45-degree field of view
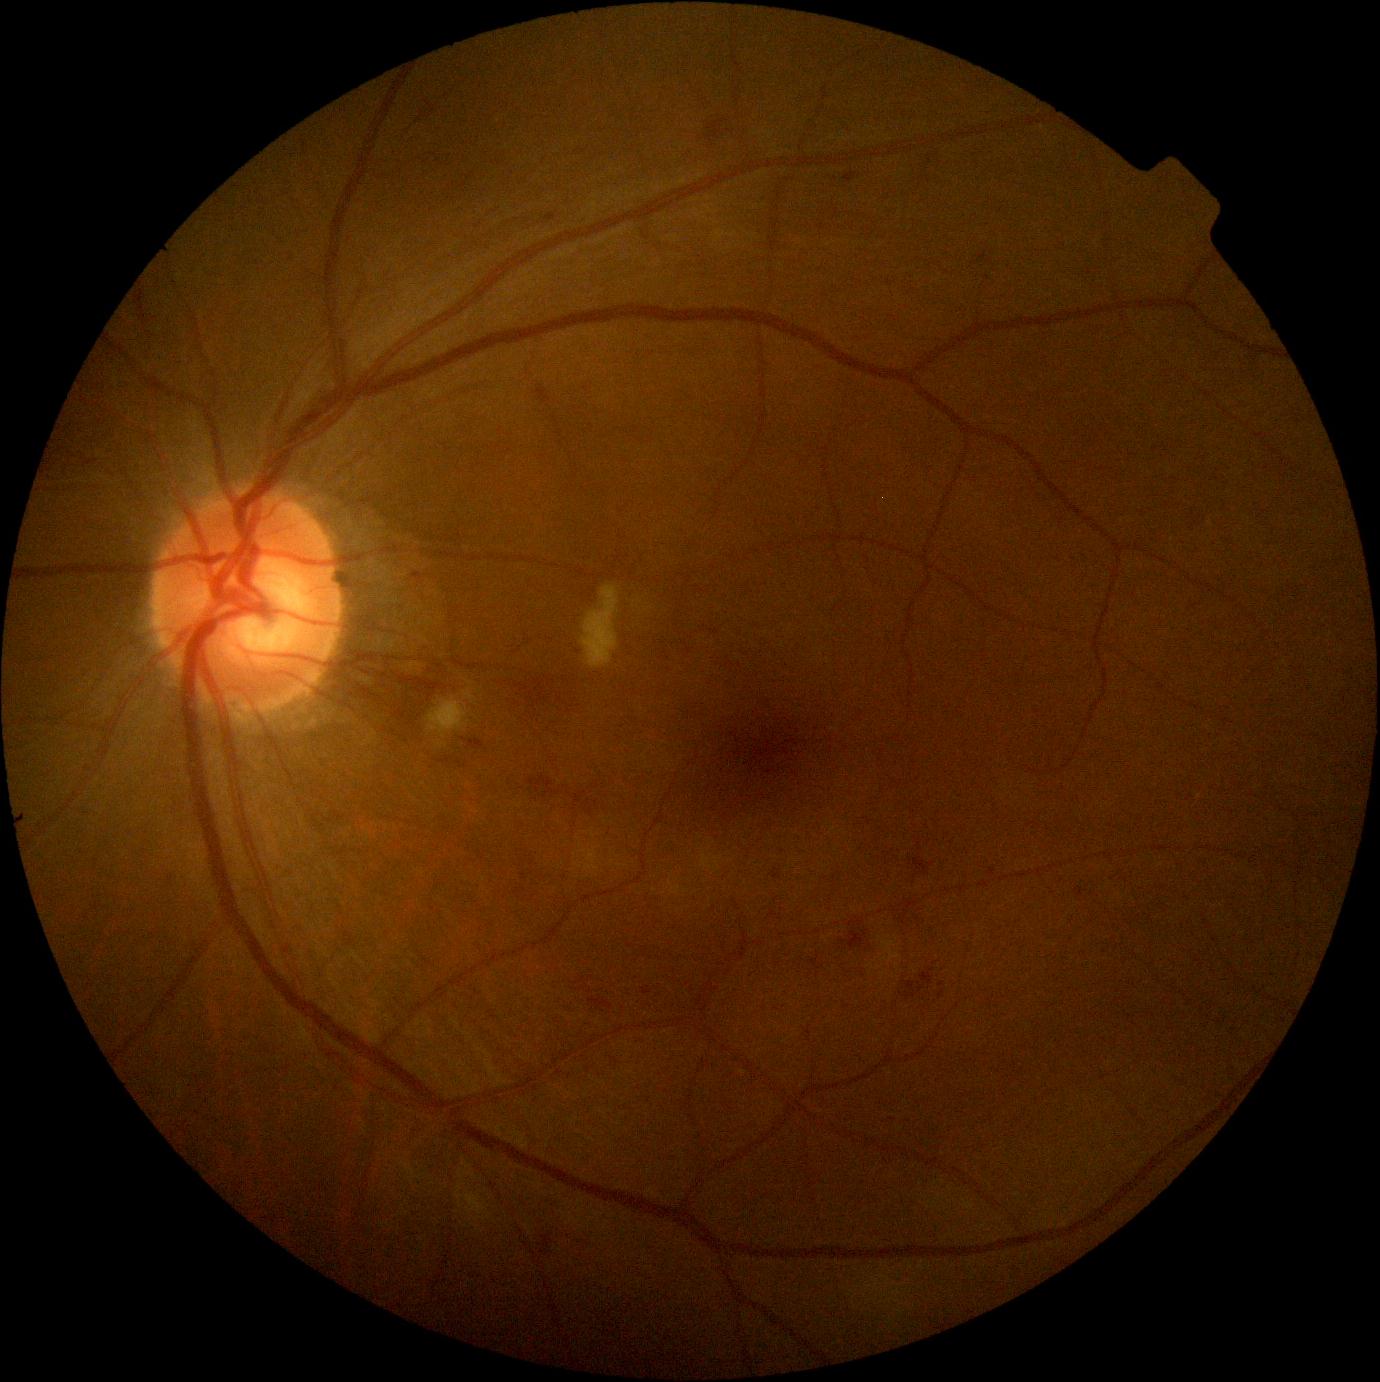
dr_grade: moderate NPDR (grade 2)
dr_category: non-proliferative diabetic retinopathy